Fundus photo; camera: Forus 3Nethra Classic fundus camera — 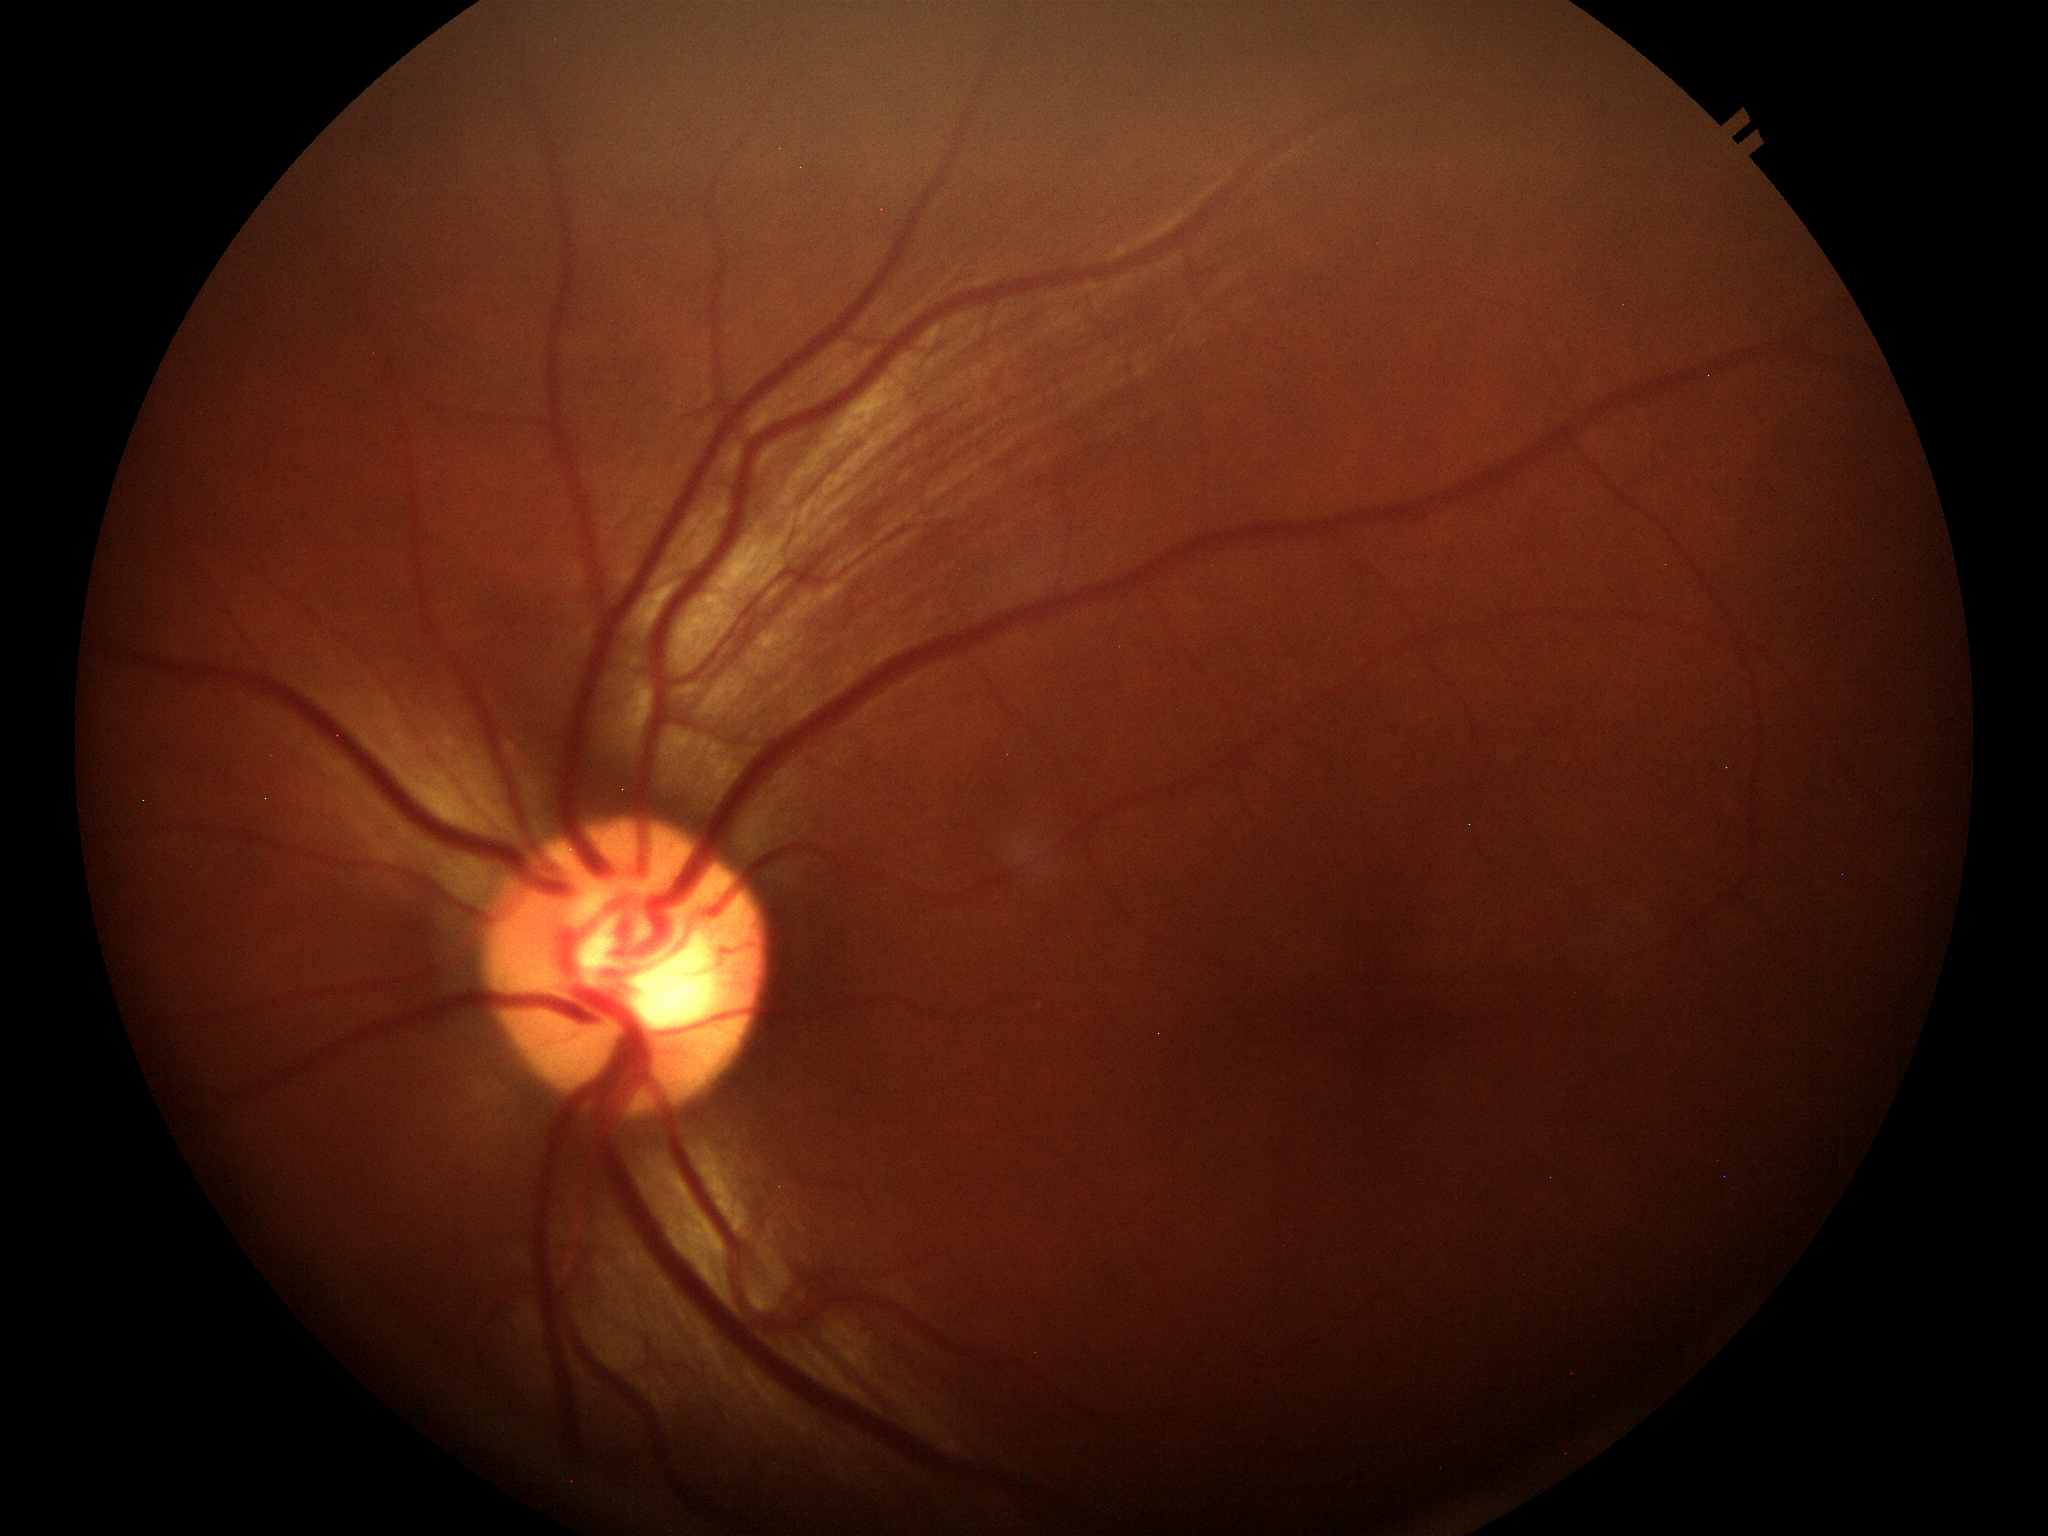
  hcdr: 0.59
  vcdr: 0.57
  glaucoma_decision: not suspect (5/5 ophthalmologists in agreement)